50° field of view — 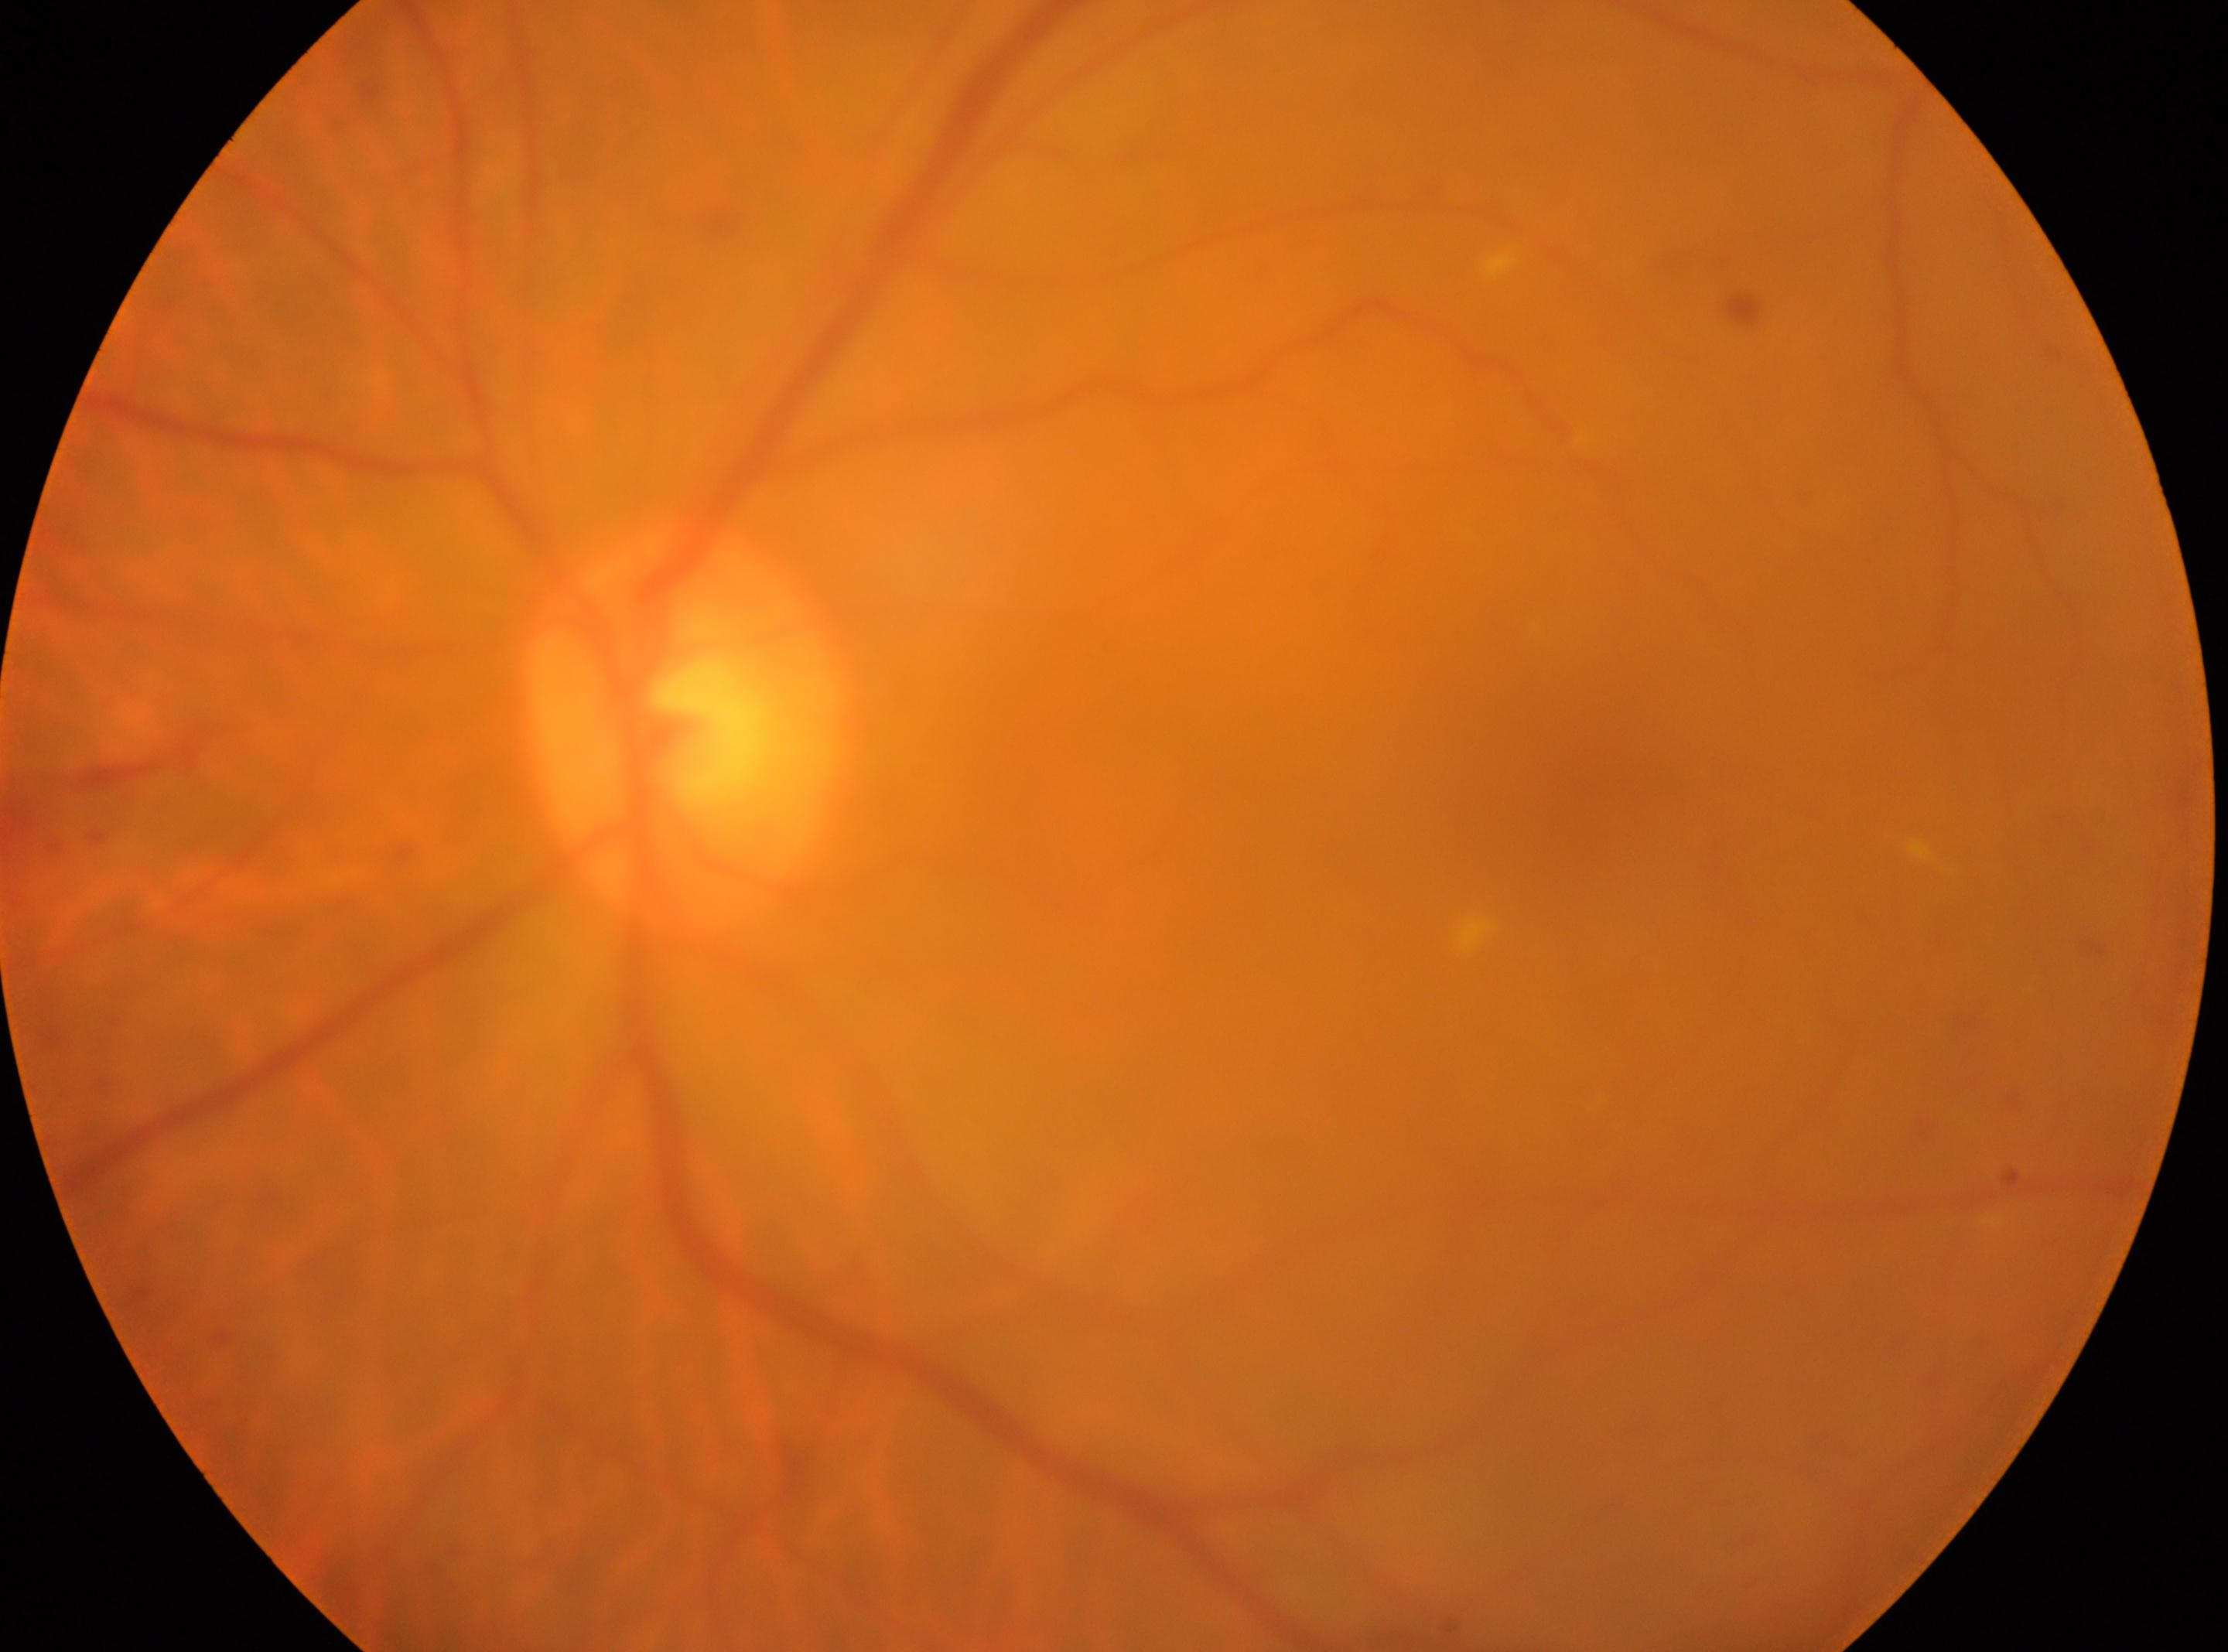

Macular center located at (1601, 794).
Retinopathy: moderate non-proliferative diabetic retinopathy (grade 2).
The optic disc center is at (678, 730).
The image shows the left eye.